Wide-field fundus photograph from neonatal ROP screening. Acquired on the Phoenix ICON. 1240x1240.
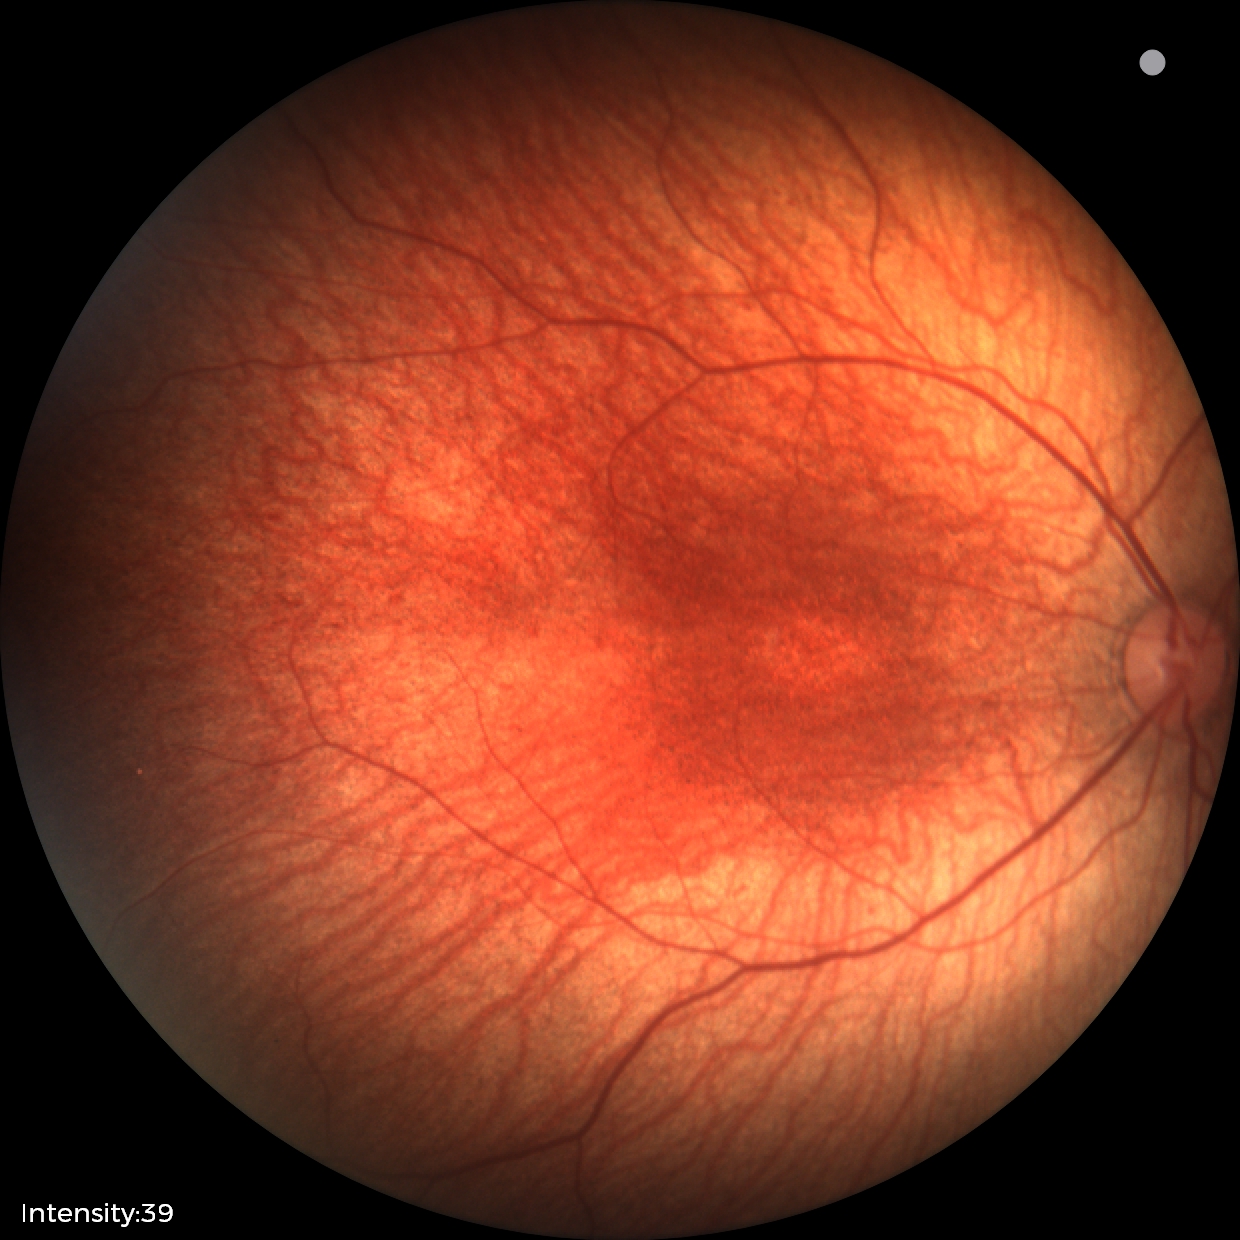
Examination with physiological retinal findings.